Mydriatic (tropicamide and phenylephrine); captured on a Topcon TRC-50DX fundus camera
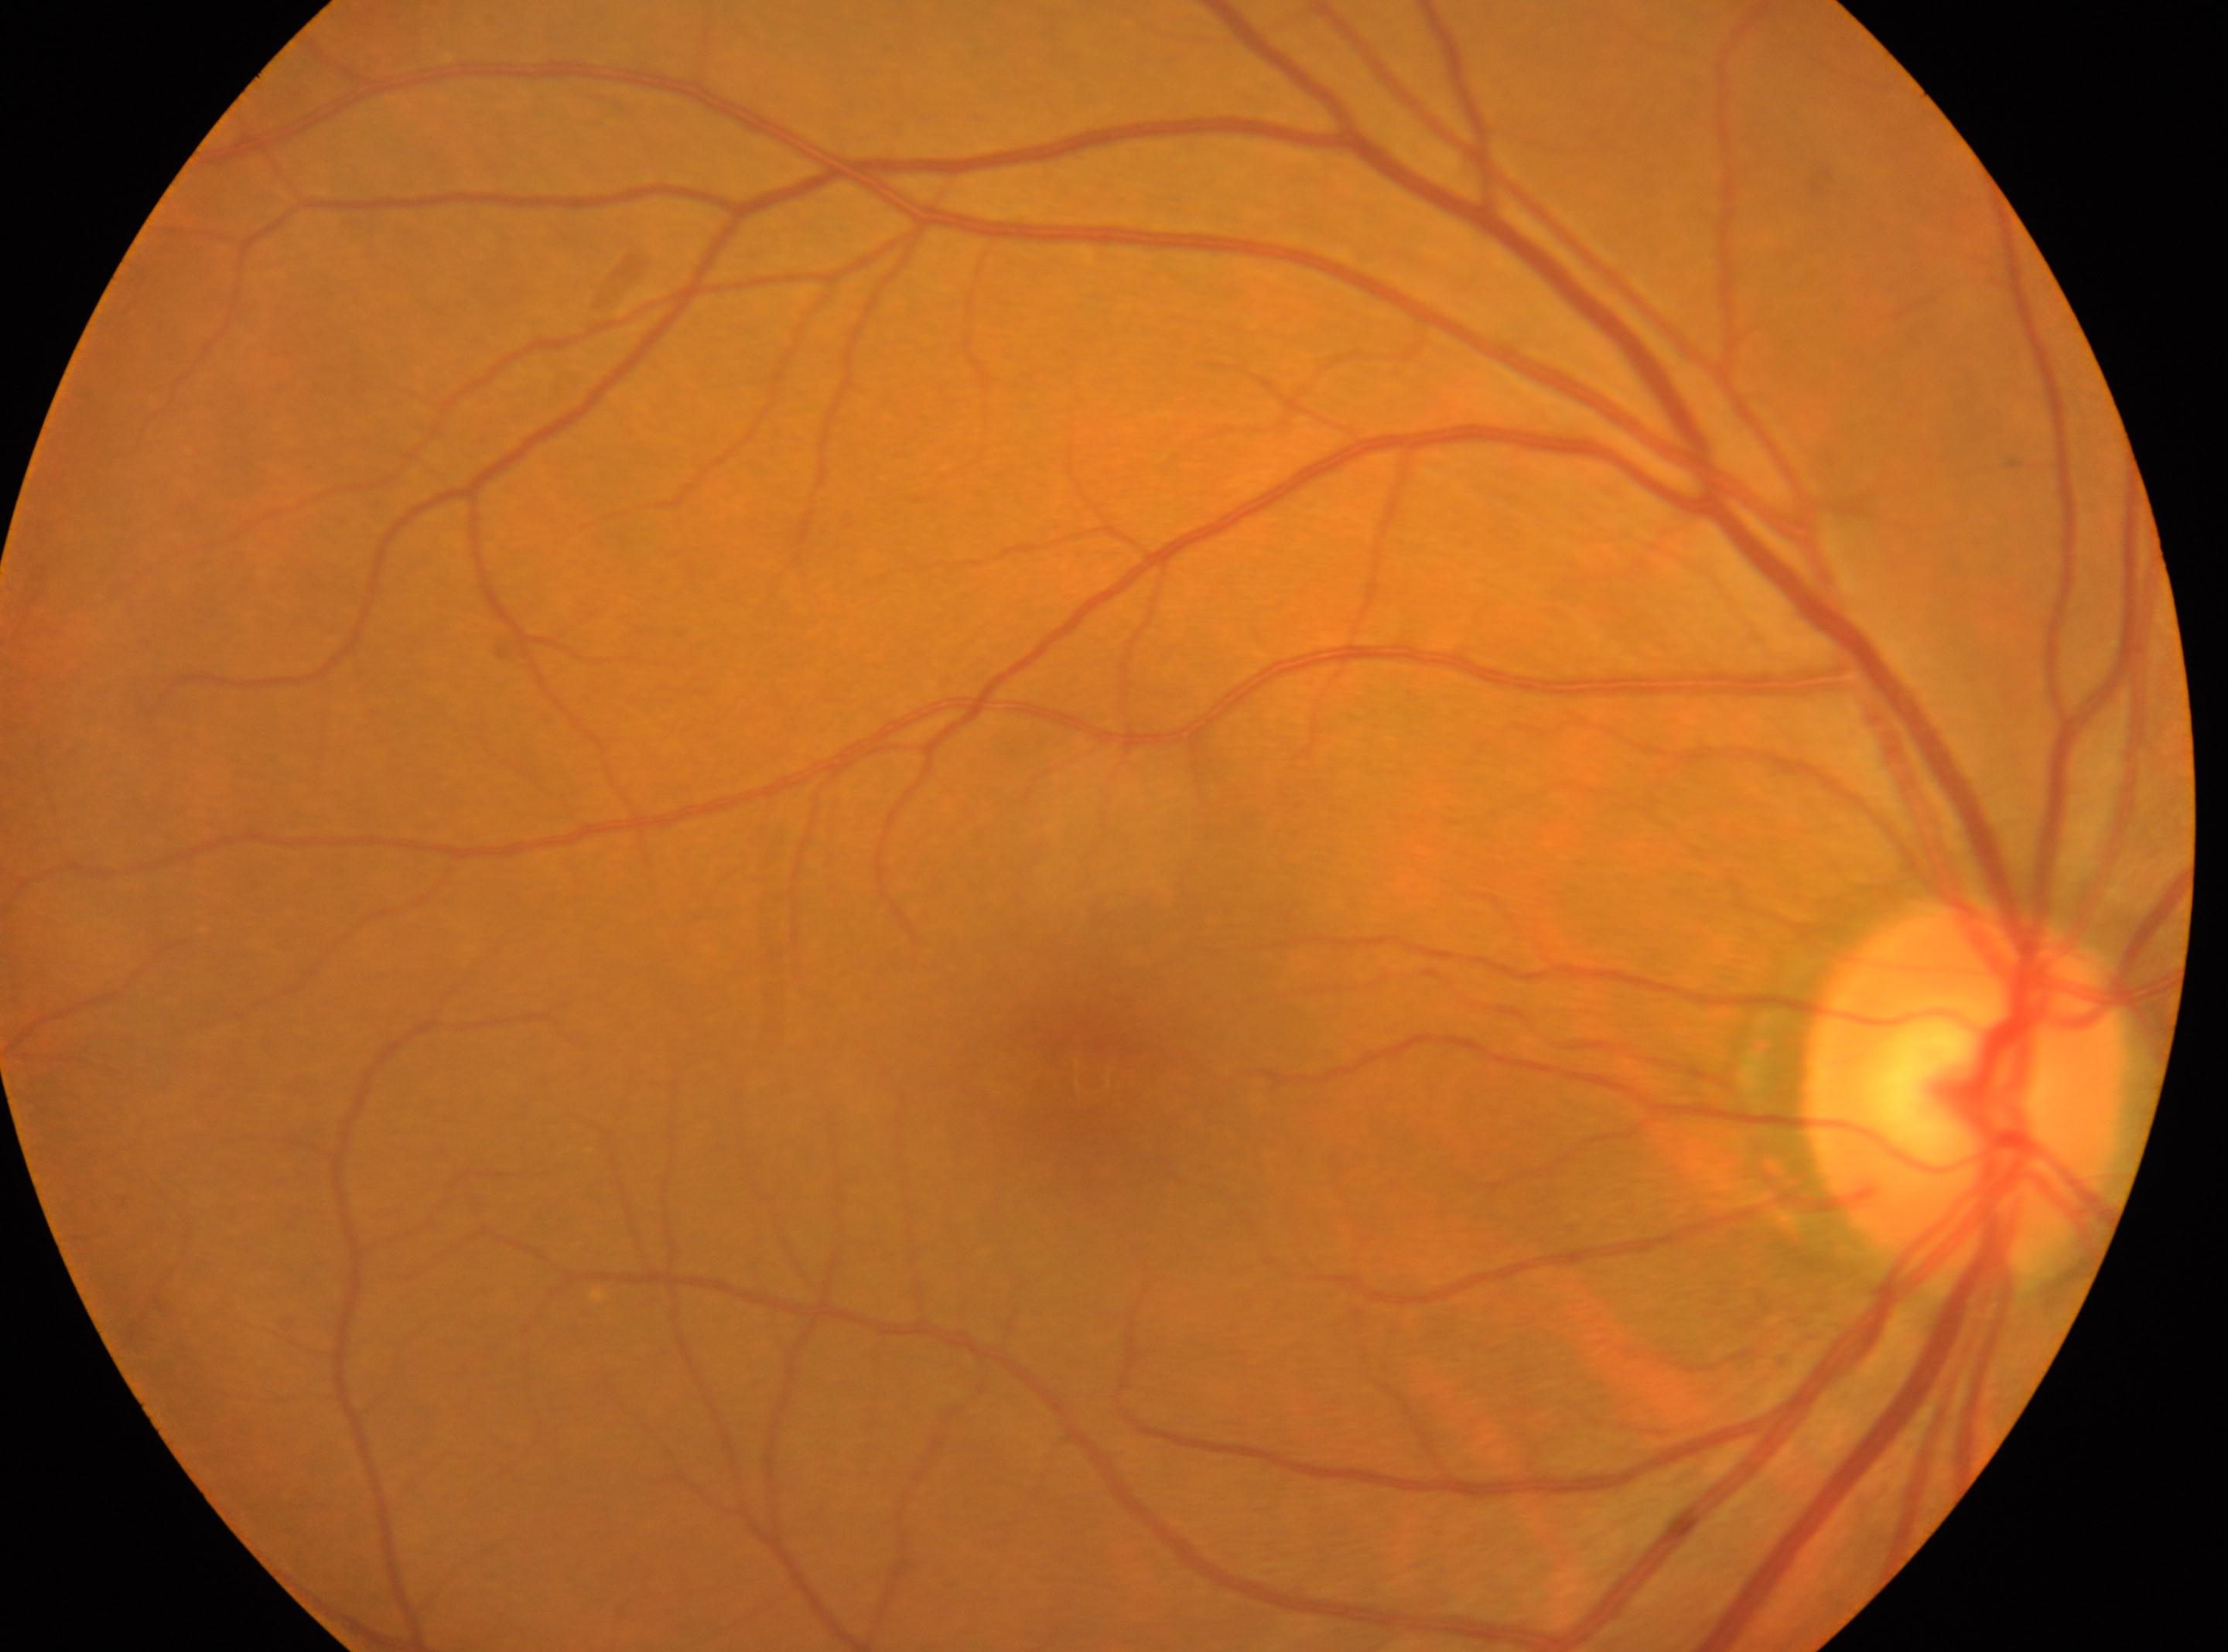
This is the oculus dexter.
DR grade: 0/4.
The fovea is at [1091, 1077].
No apparent diabetic retinopathy.
Optic disc center located at [1963, 1086].